45-degree field of view
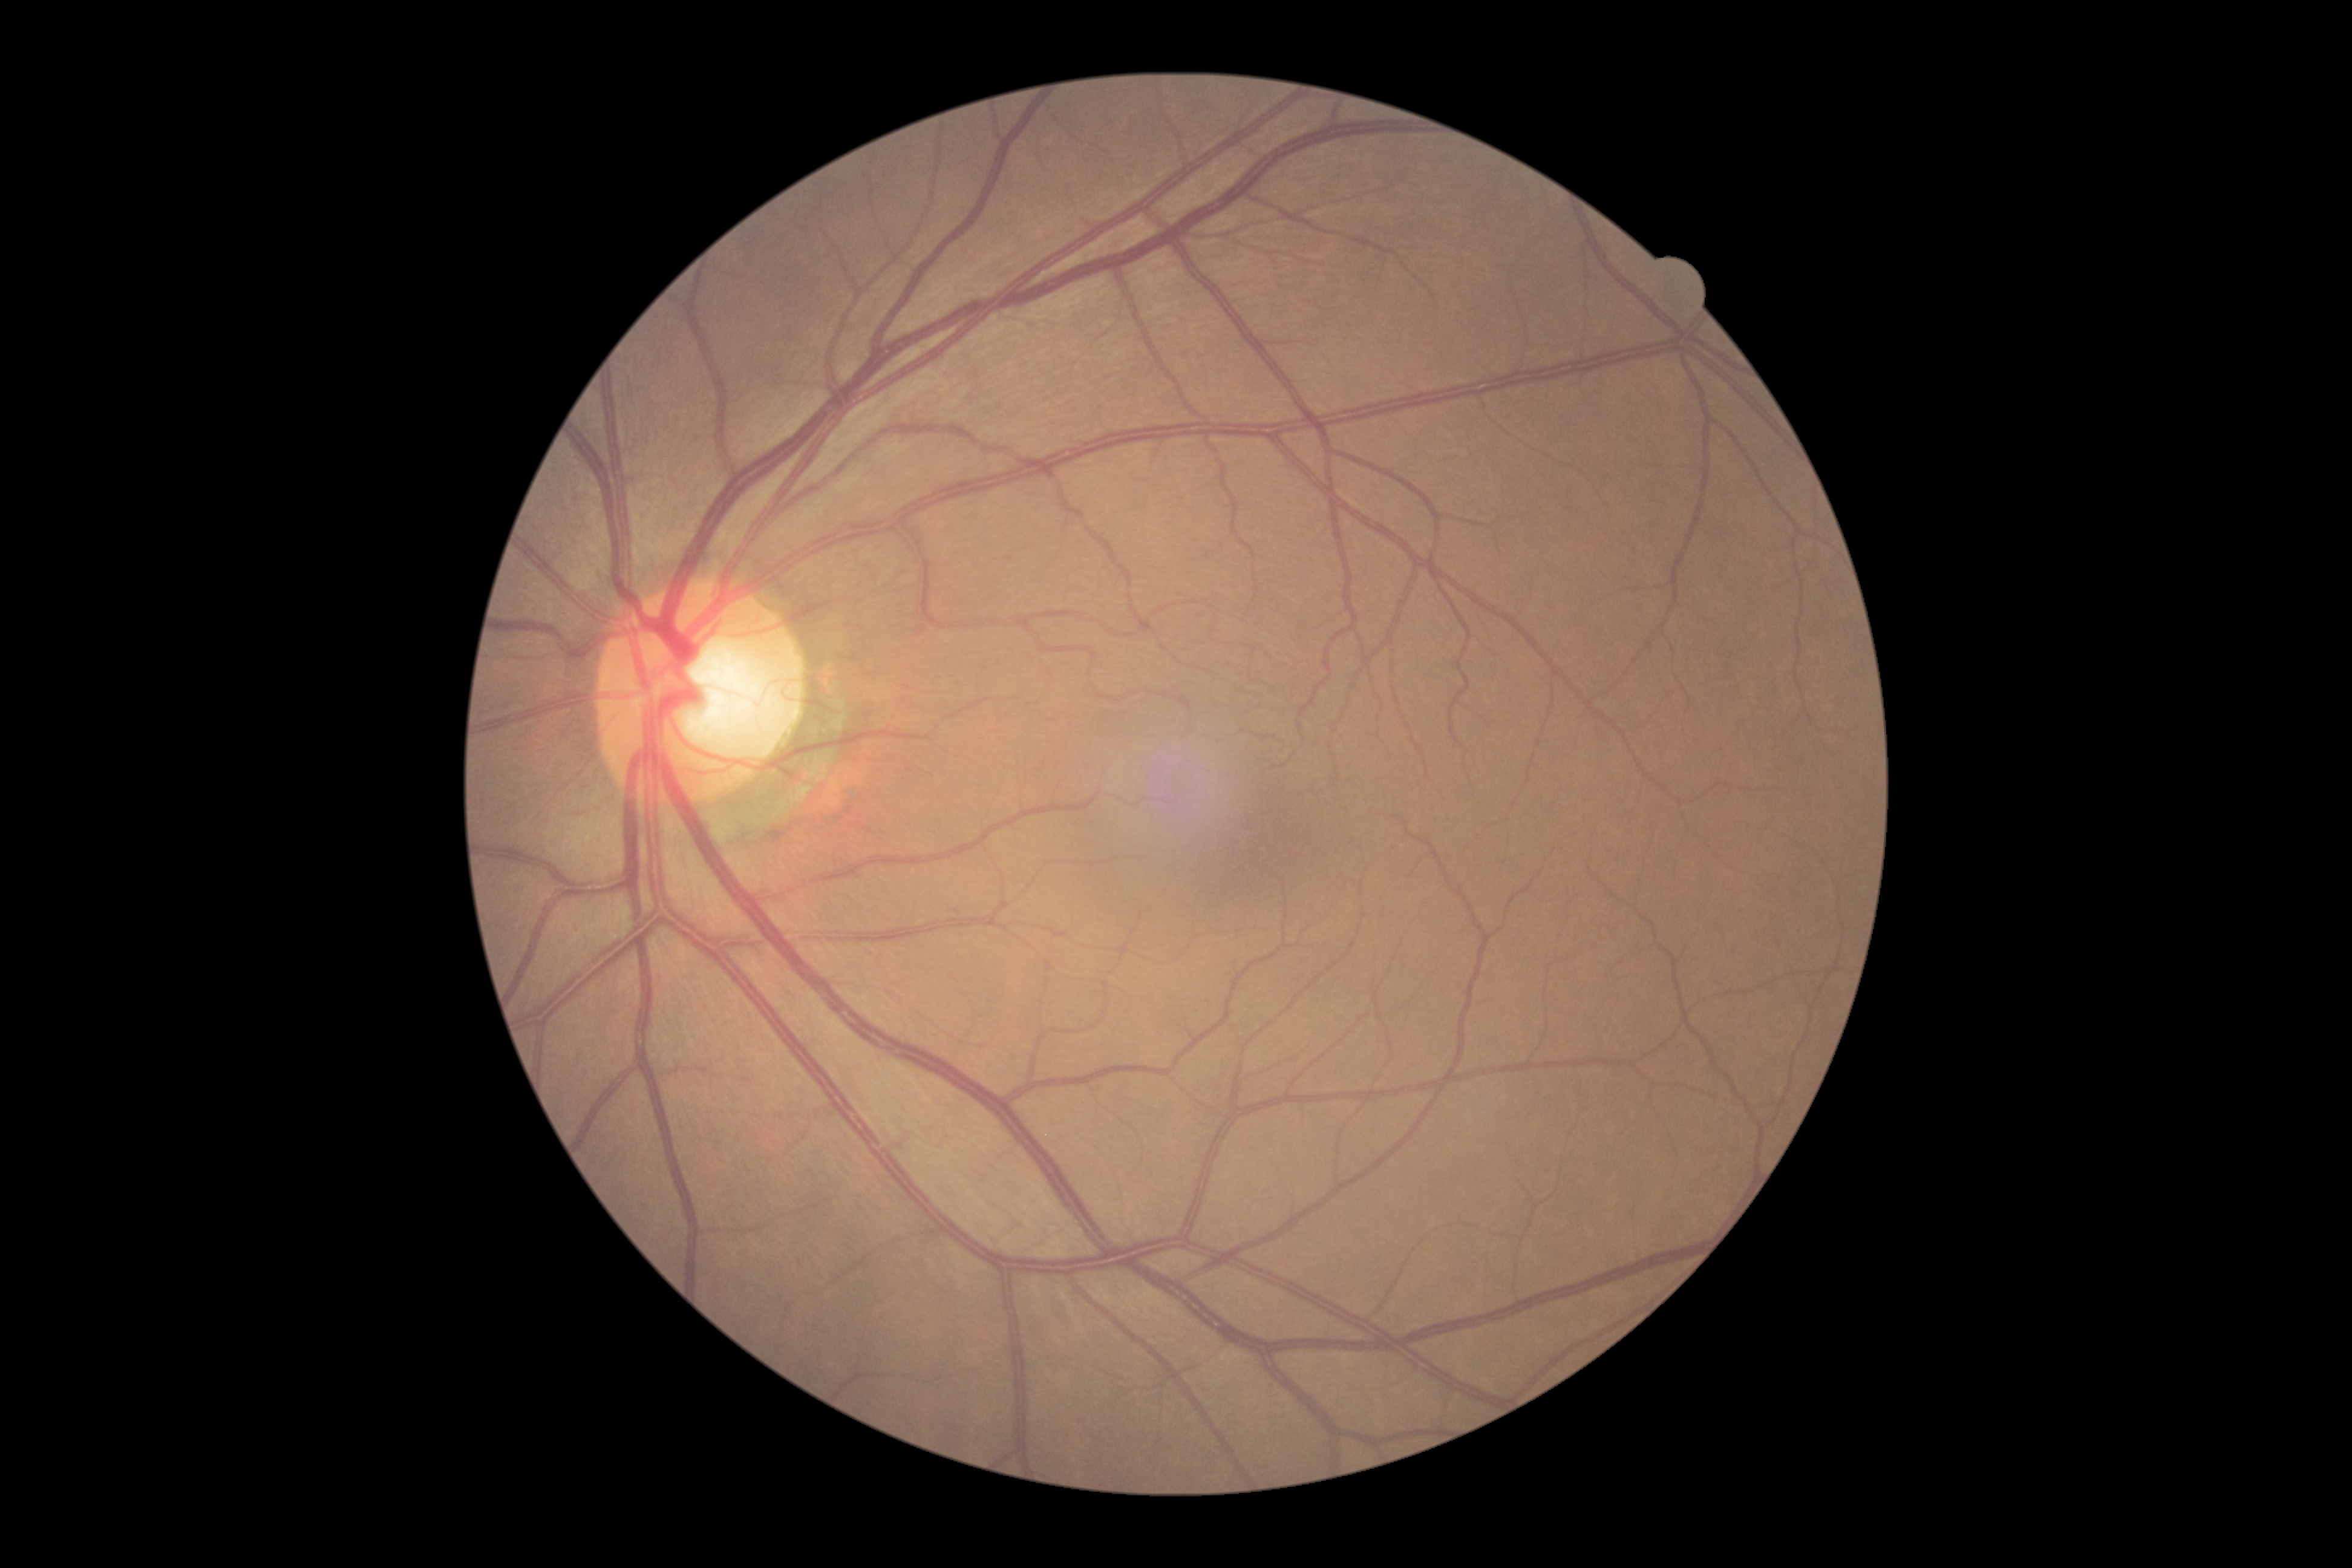
DR: no apparent retinopathy (grade 0).